Captured after pupil dilation
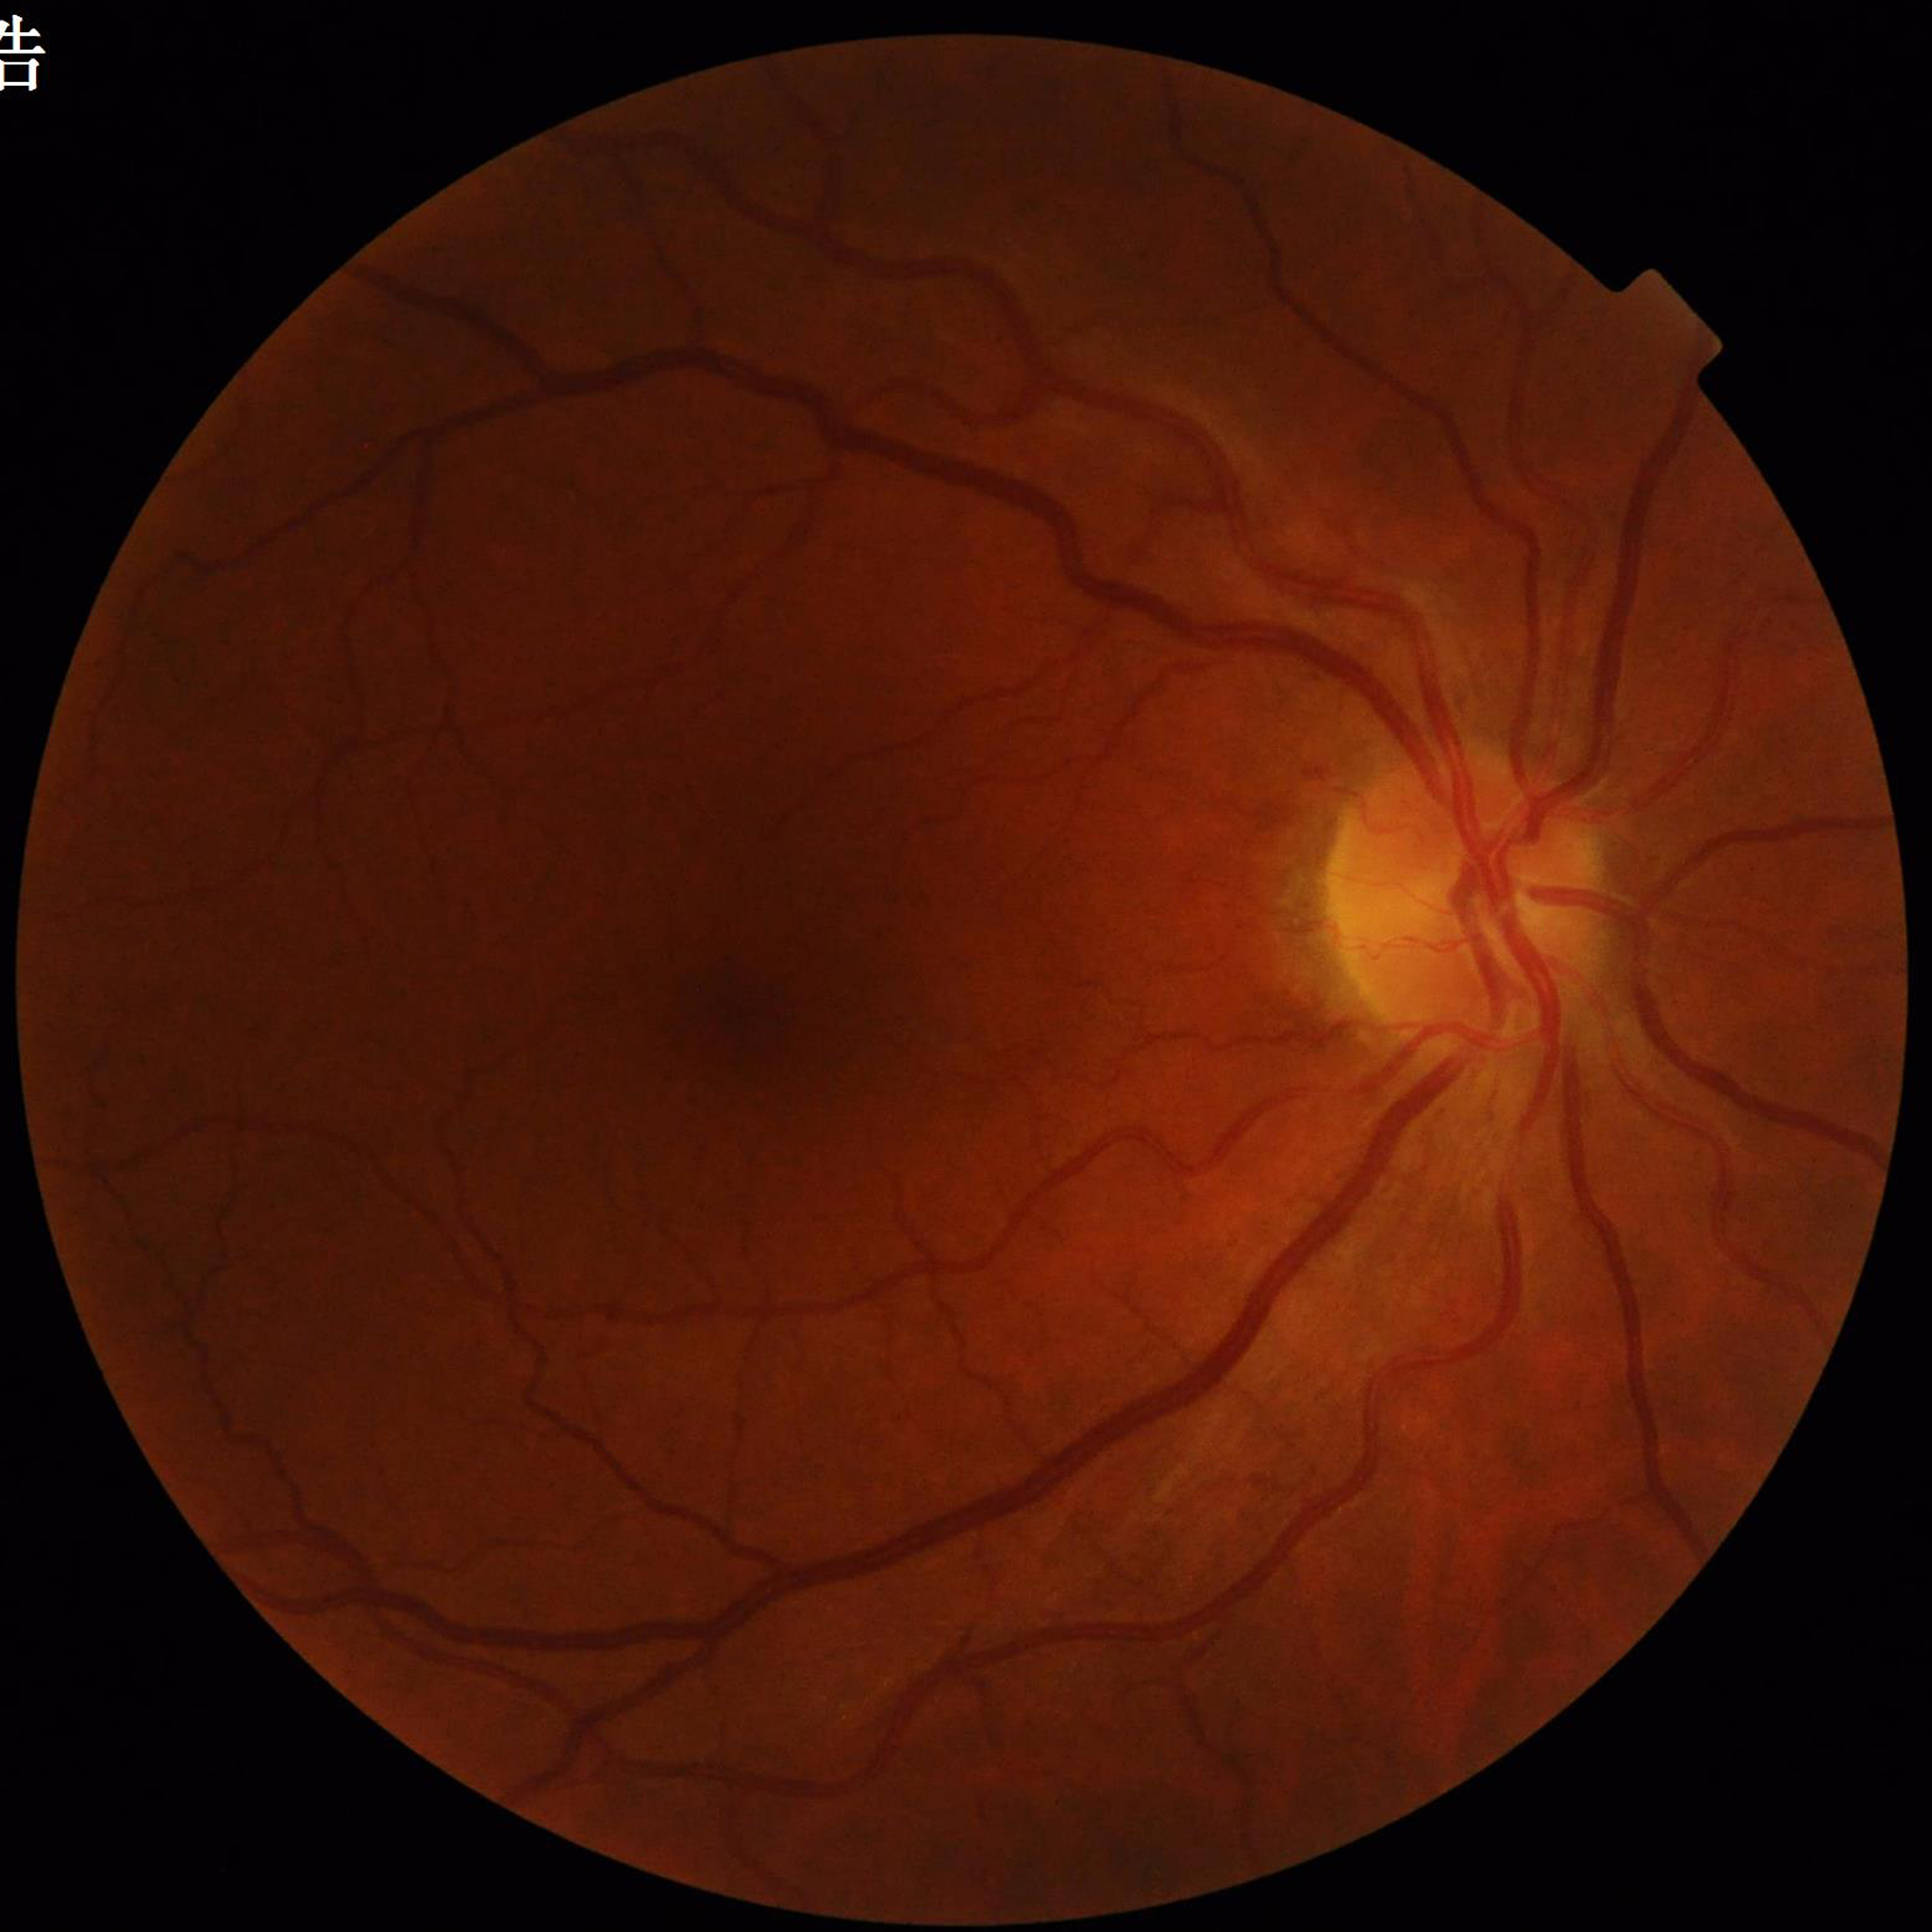 Retinal fundus photograph from a patient with DR.